Modified Davis classification
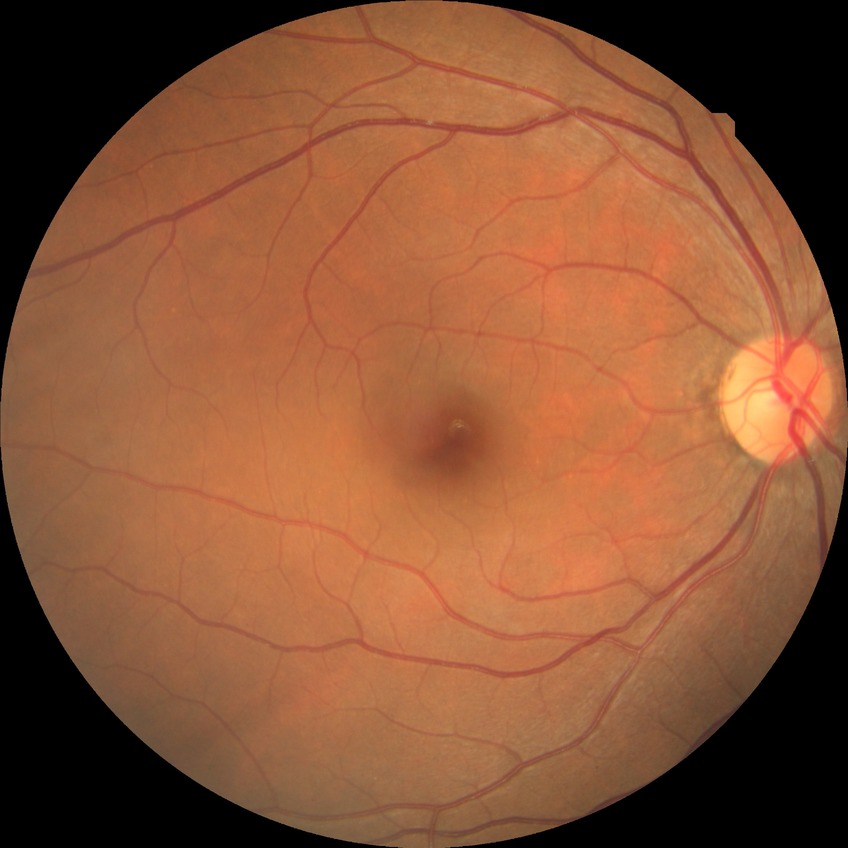

Diabetic retinopathy (DR): NDR (no diabetic retinopathy).